Color fundus photograph, 50° FOV: 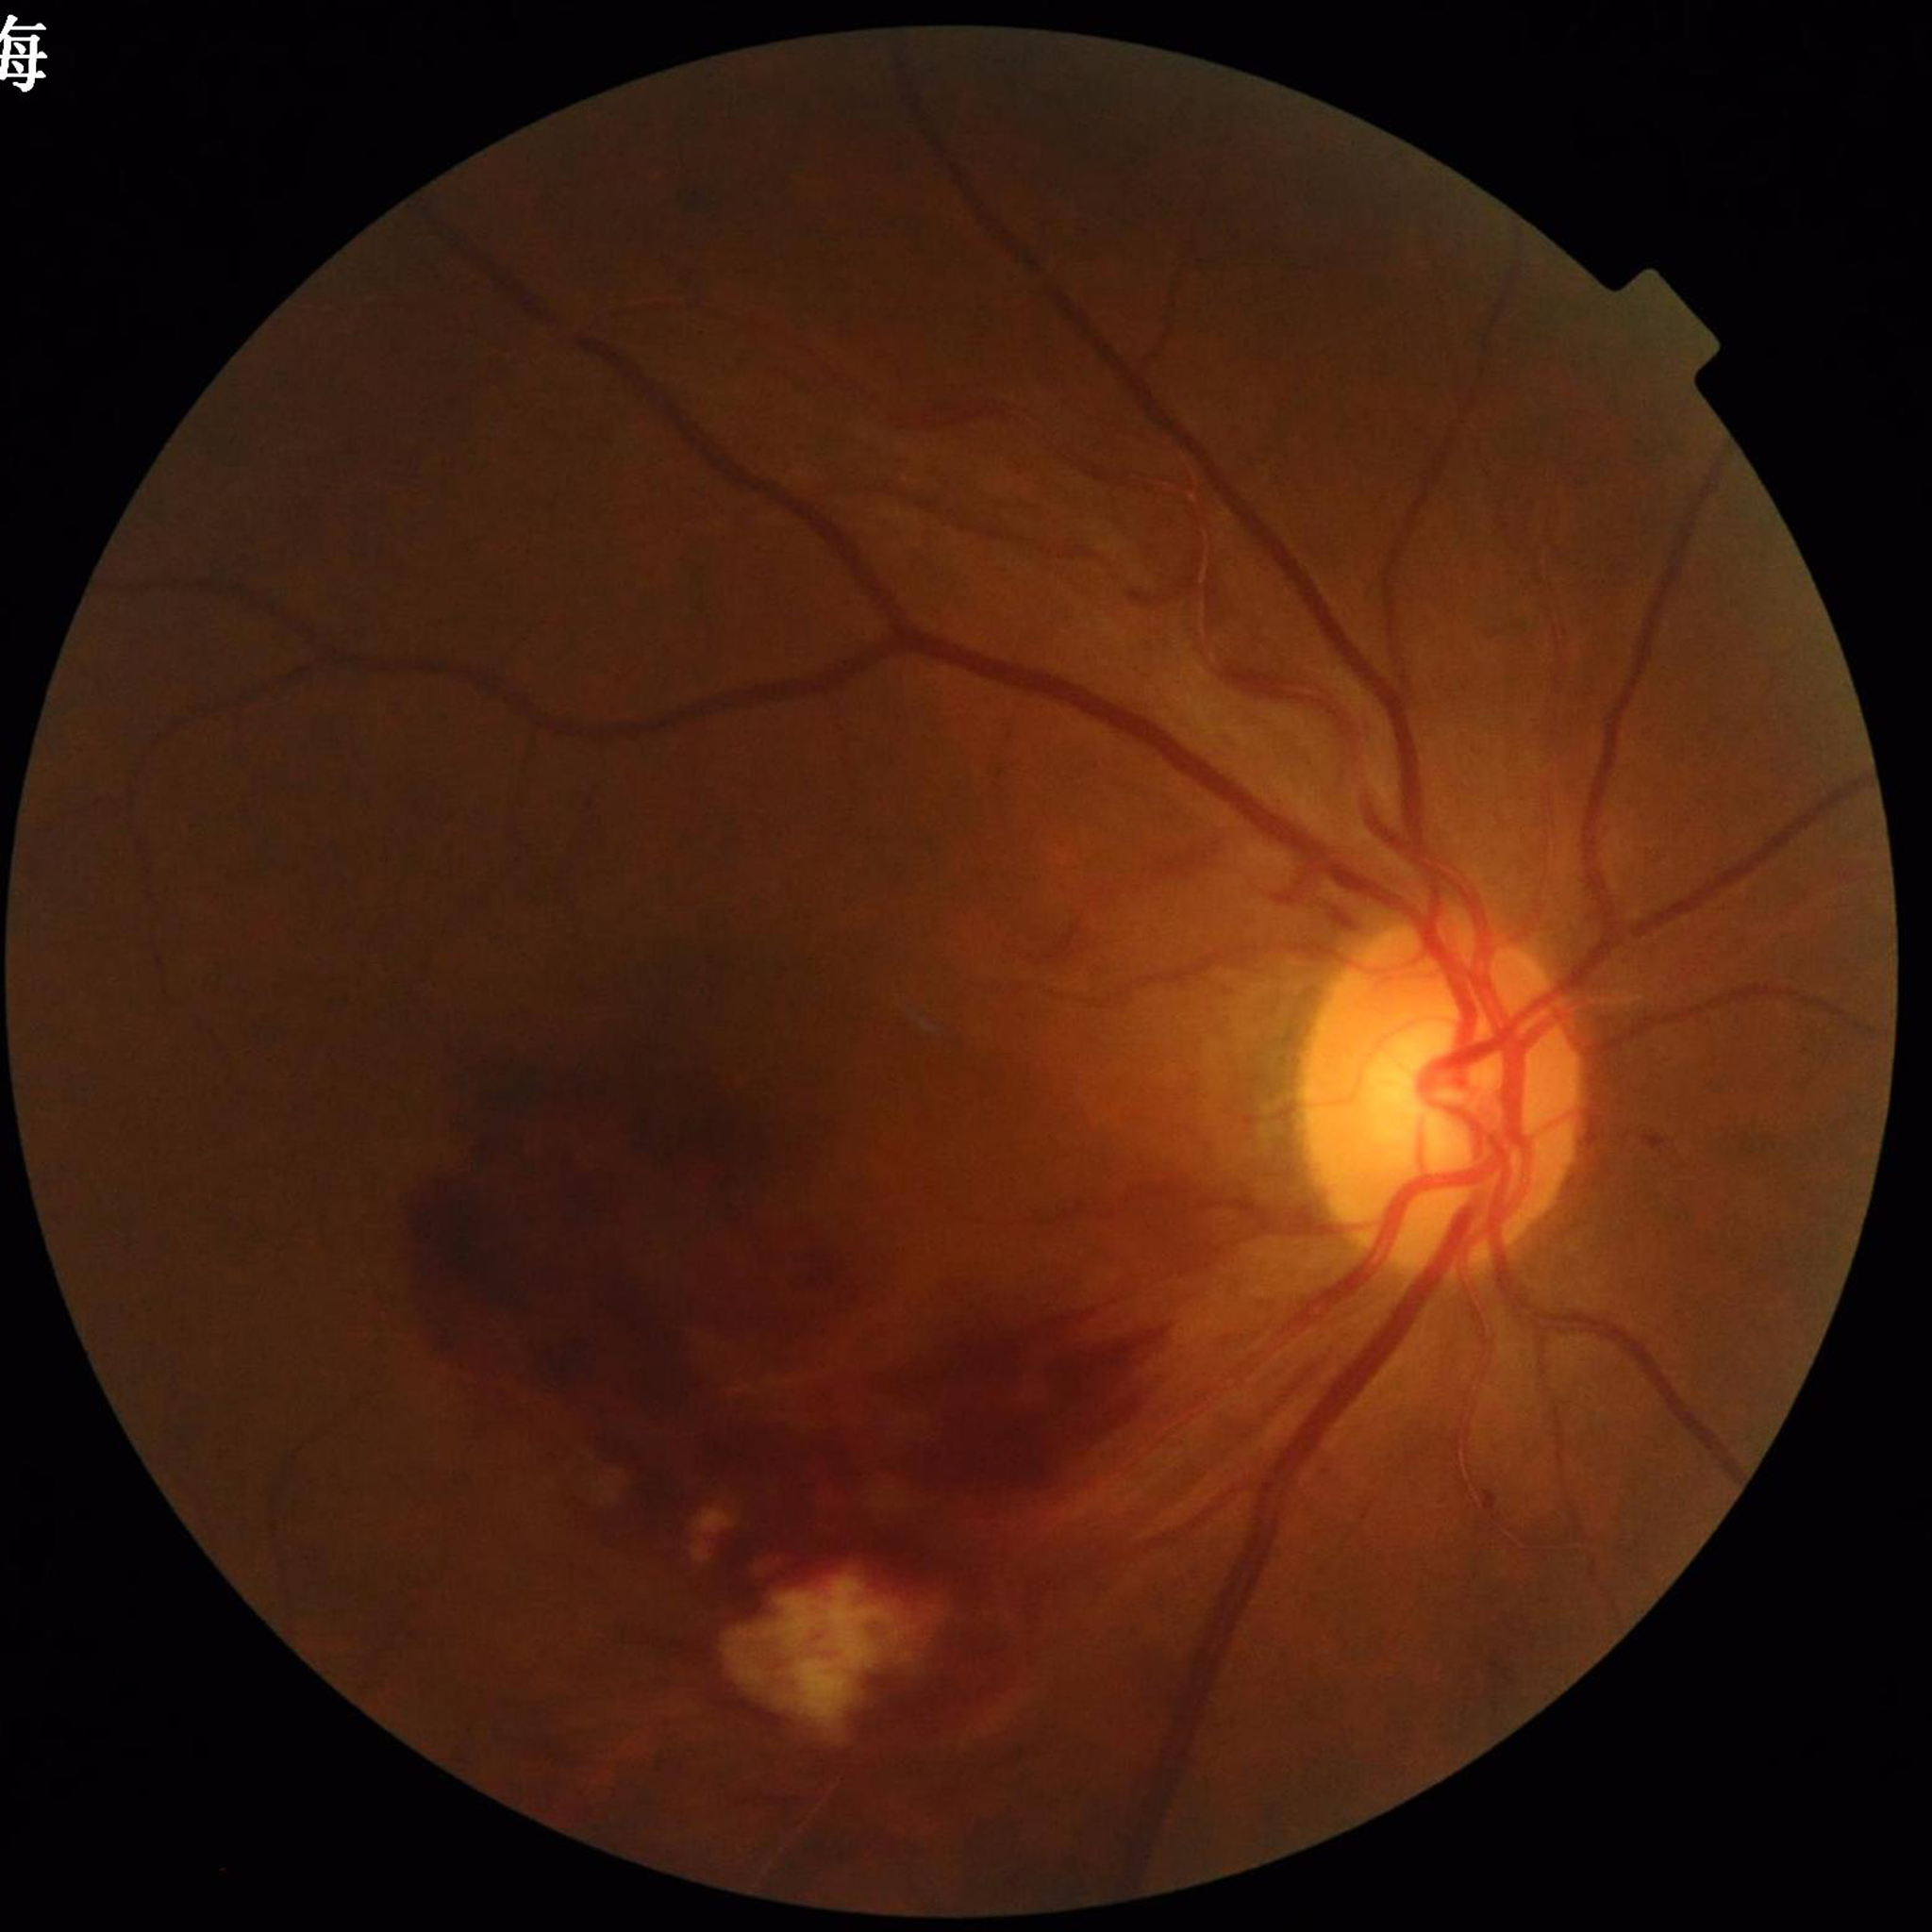
Photo quality: no blur, illumination and color satisfactory, contrast adequate; Diagnosis: glaucoma.